Fundus photo.
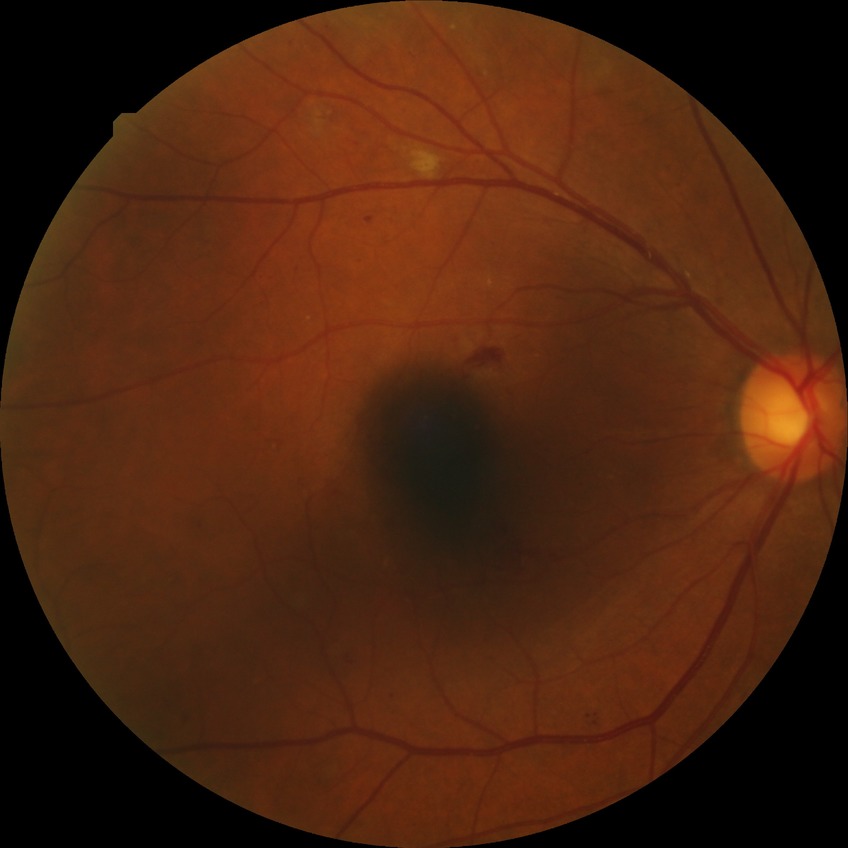
davis_grade: pre-proliferative diabetic retinopathy (PPDR)